2048 x 1536 pixels:
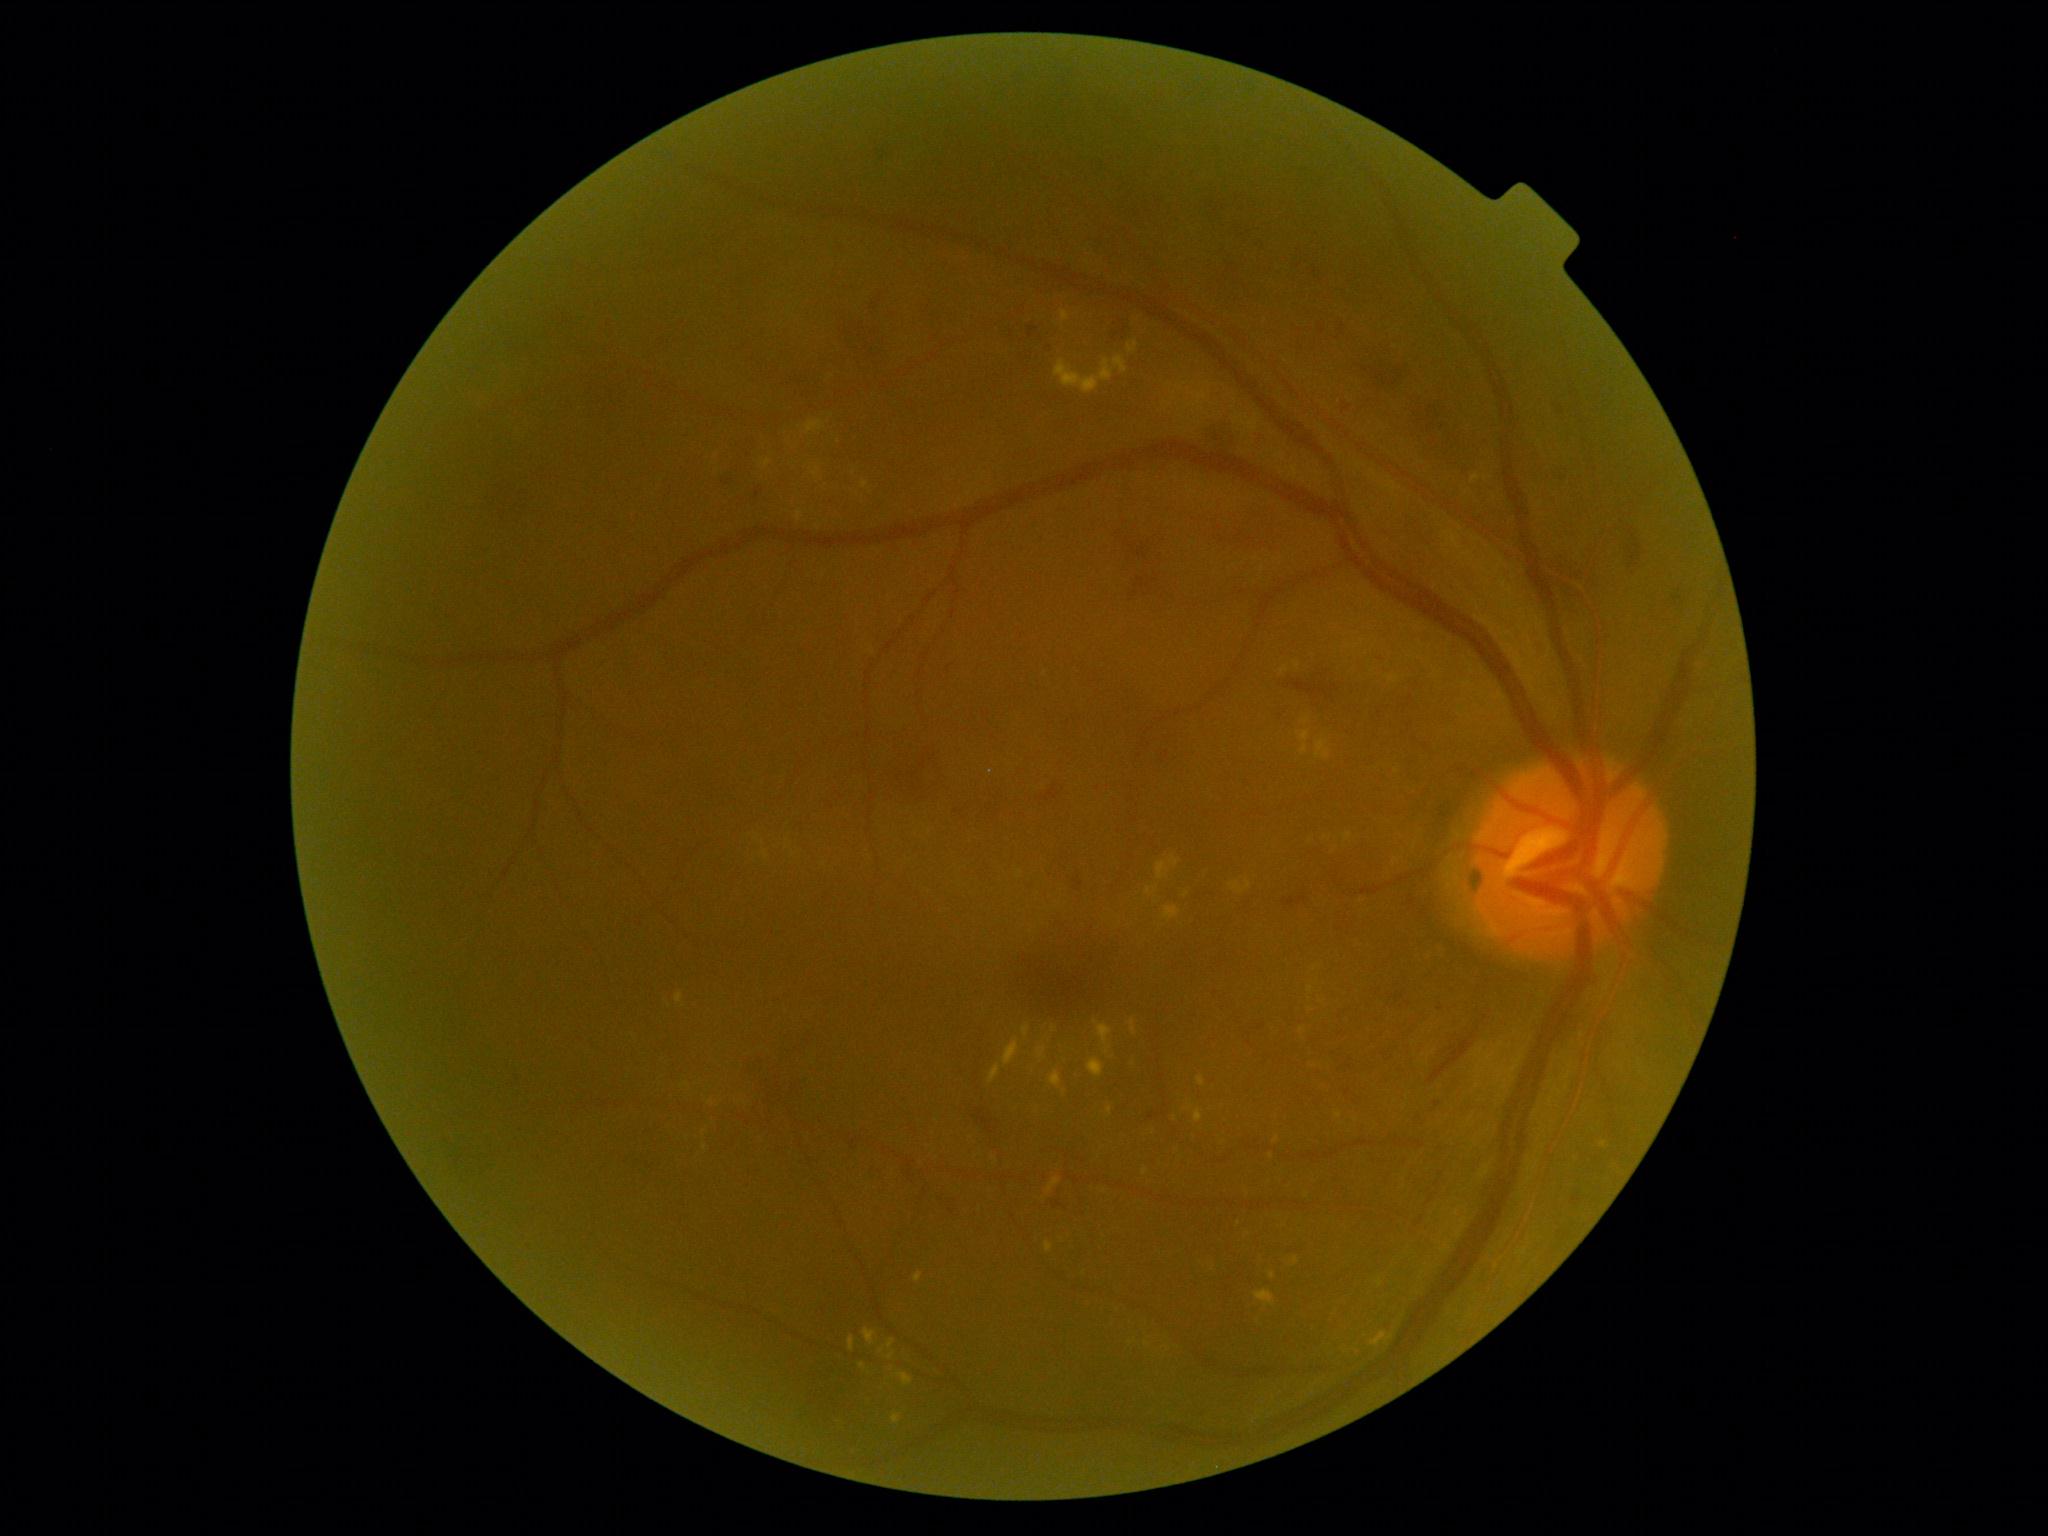

Diabetic retinopathy (DR) is grade 2
Lesions identified (partial list):
hard exudates (EXs) (continued): BBox(1113, 357, 1128, 374); BBox(1093, 1021, 1113, 1056); BBox(702, 1144, 708, 1152); BBox(1046, 1242, 1053, 1253); BBox(1088, 1059, 1105, 1079); BBox(1255, 1291, 1275, 1306); BBox(1146, 887, 1159, 897); BBox(1471, 474, 1482, 483); BBox(887, 1352, 896, 1361); BBox(812, 468, 821, 479); BBox(864, 1329, 877, 1345); BBox(1108, 1107, 1113, 1116); BBox(1600, 1142, 1608, 1147); BBox(1377, 1279, 1384, 1288)
EXs (small, approximate centers) near Point(1397, 772); Point(991, 772); Point(1054, 1029); Point(1315, 969); Point(1396, 861)
hemorrhages (HEs) (continued): BBox(873, 148, 897, 171); BBox(1343, 405, 1351, 414); BBox(1201, 523, 1269, 553); BBox(1429, 1034, 1476, 1084); BBox(1052, 1202, 1063, 1210); BBox(1073, 878, 1083, 891); BBox(1629, 530, 1635, 539); BBox(1040, 786, 1060, 802); BBox(1418, 407, 1454, 443); BBox(1360, 362, 1408, 395); BBox(907, 1160, 916, 1180); BBox(791, 374, 837, 410)
HEs (small, approximate centers) near Point(1117, 336); Point(749, 455); Point(1382, 660); Point(956, 811)